Phoenix ICON wide-field infant fundus image: 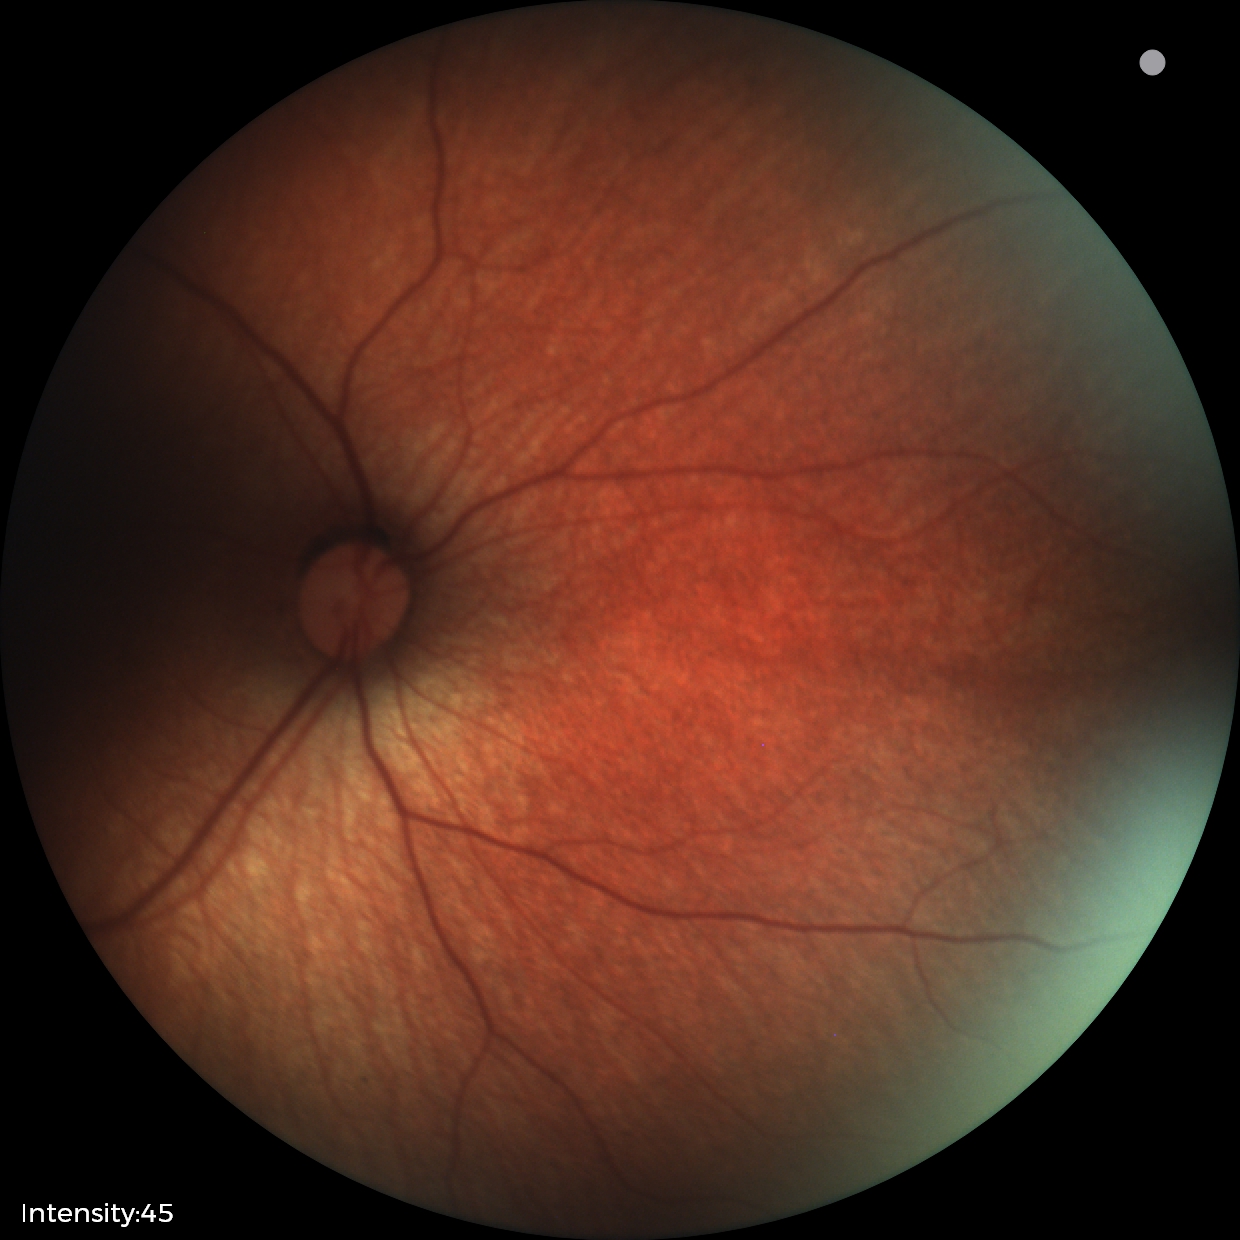
Screening examination diagnosed as physiological.